640x480px. Pediatric wide-field fundus photograph: 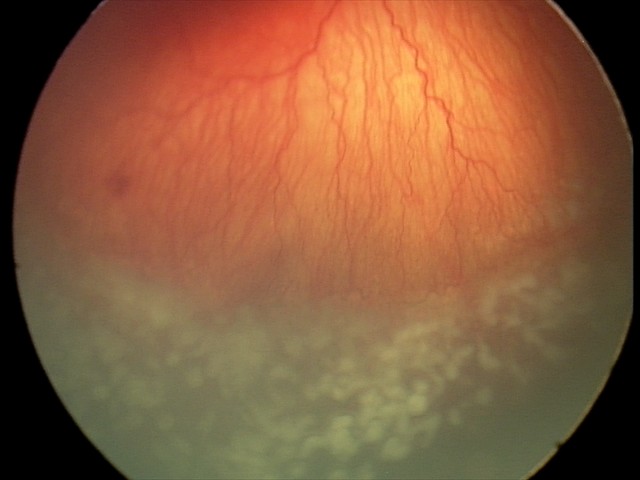 Screening: A-ROP (aggressive ROP) | plus disease.